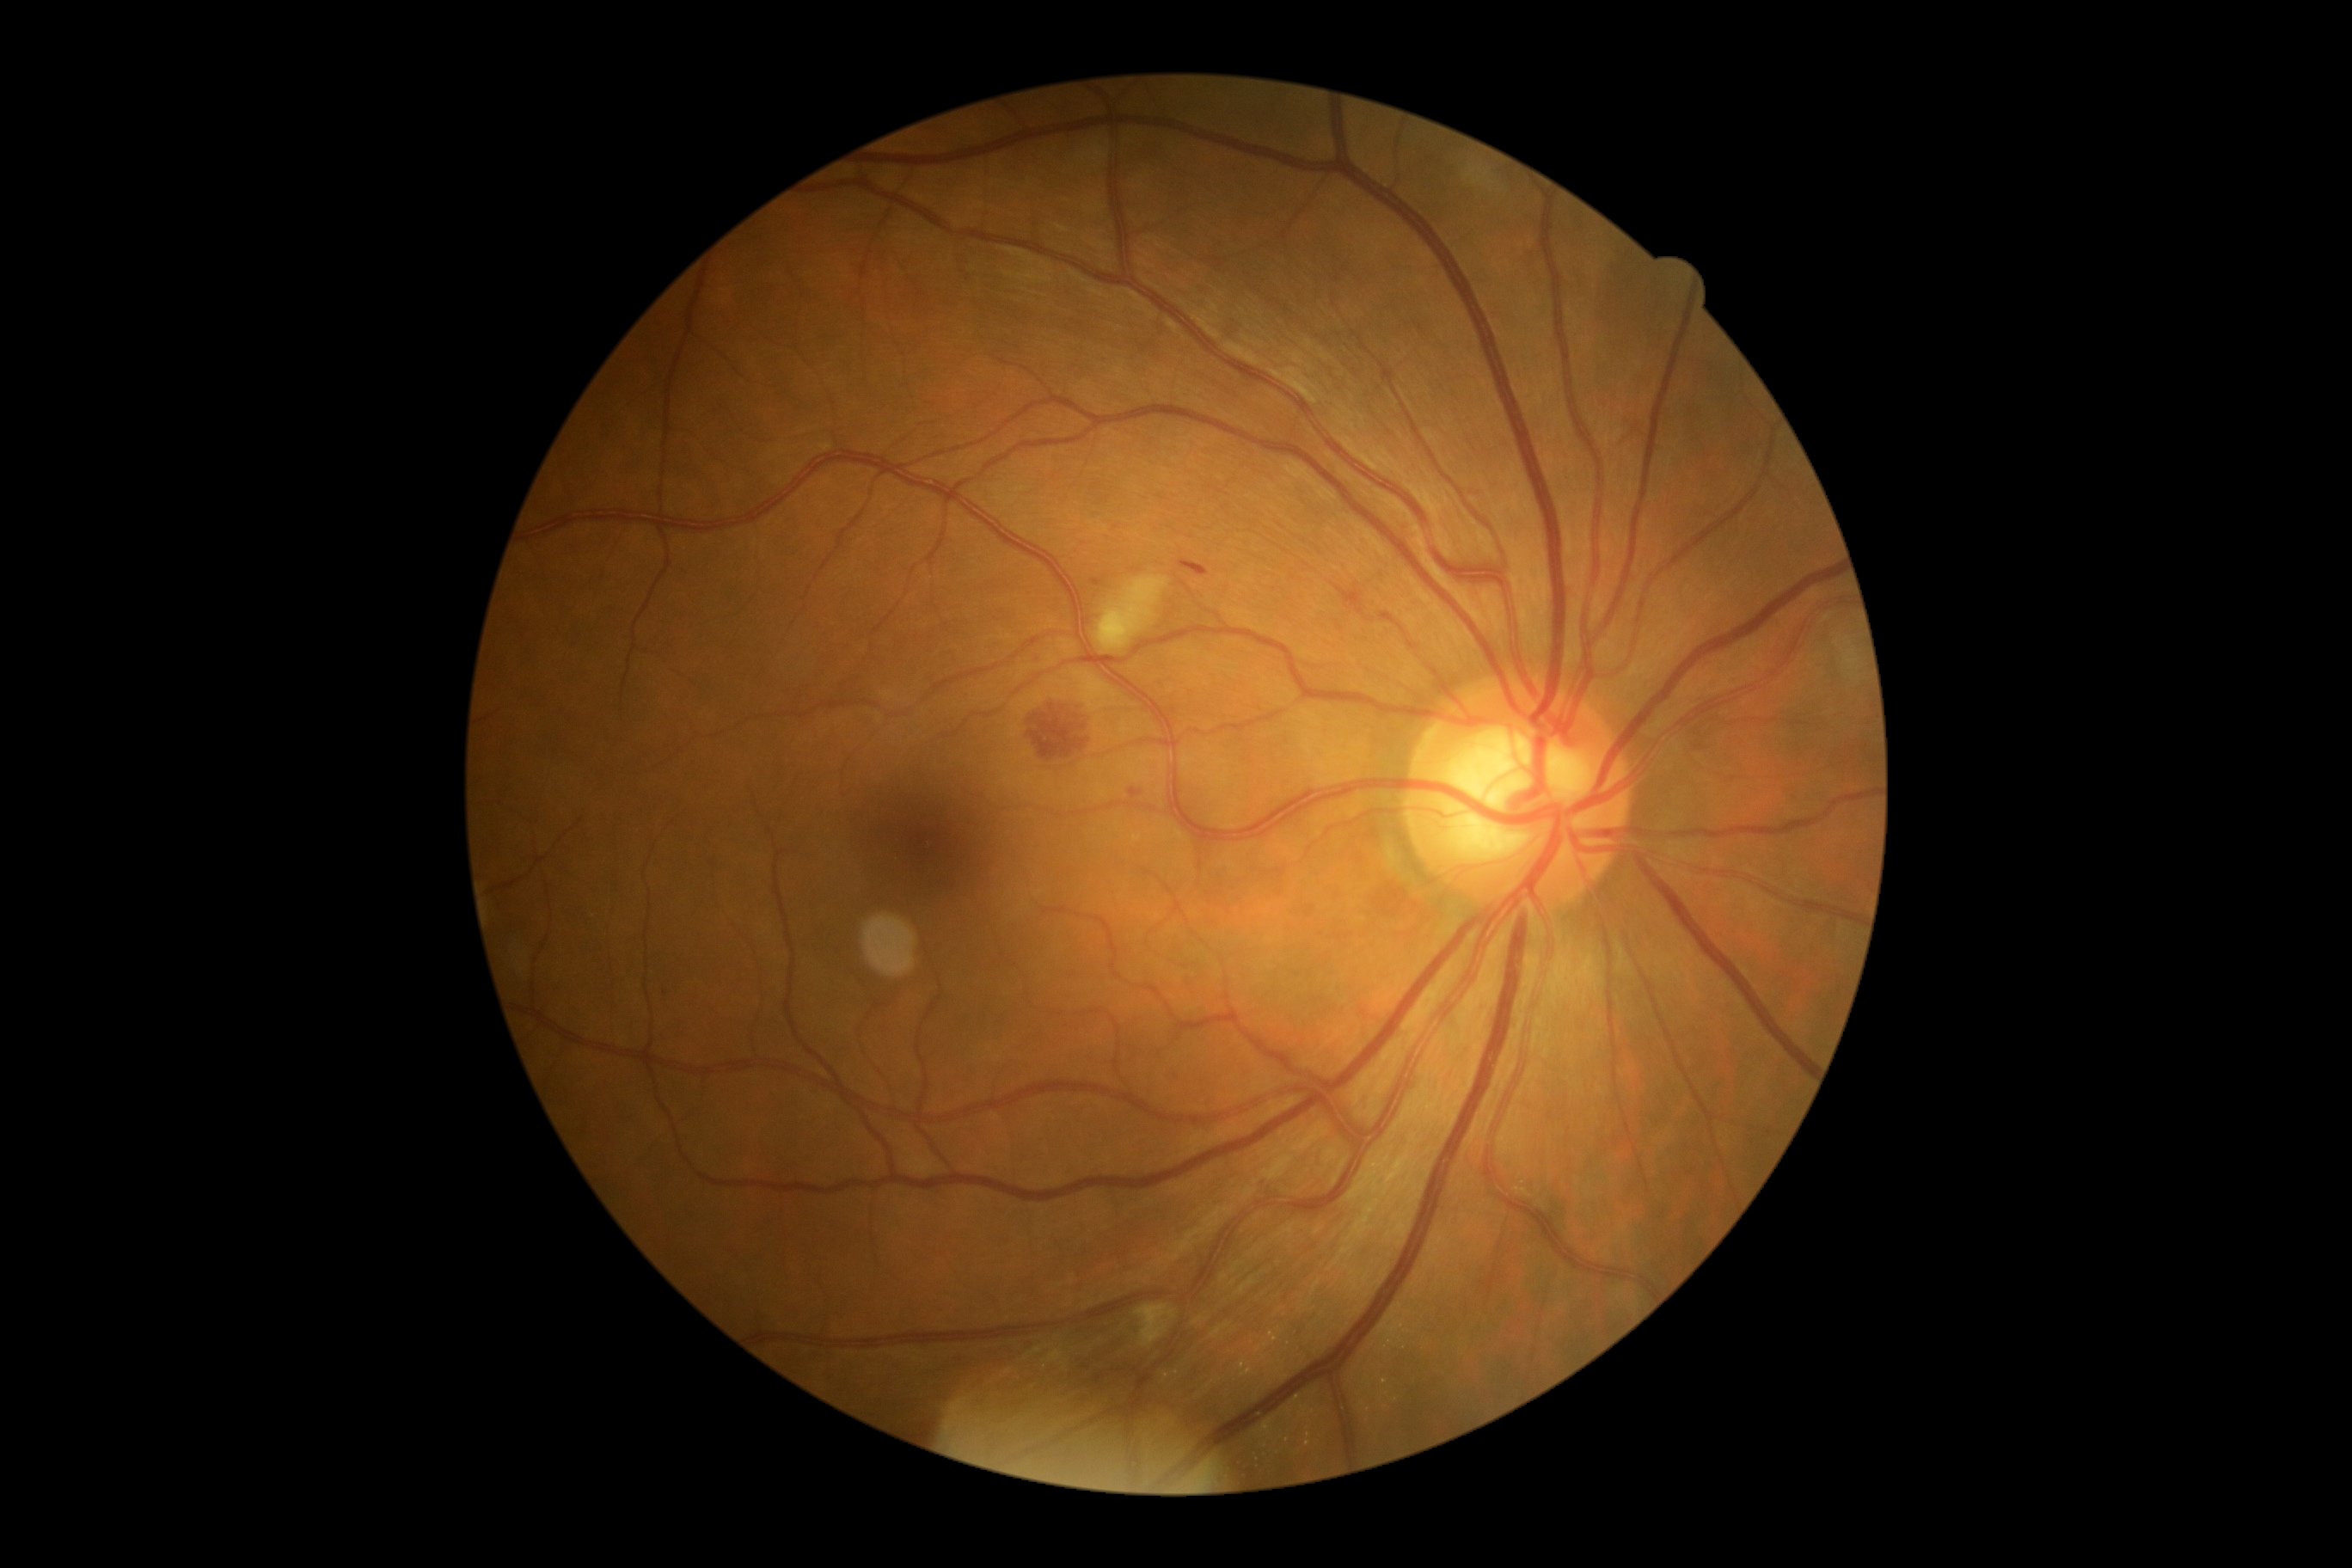 DR severity: moderate NPDR (grade 2) — more than just microaneurysms but less than severe NPDR.